45° FOV, retinal fundus photograph, 2352 x 1568 pixels
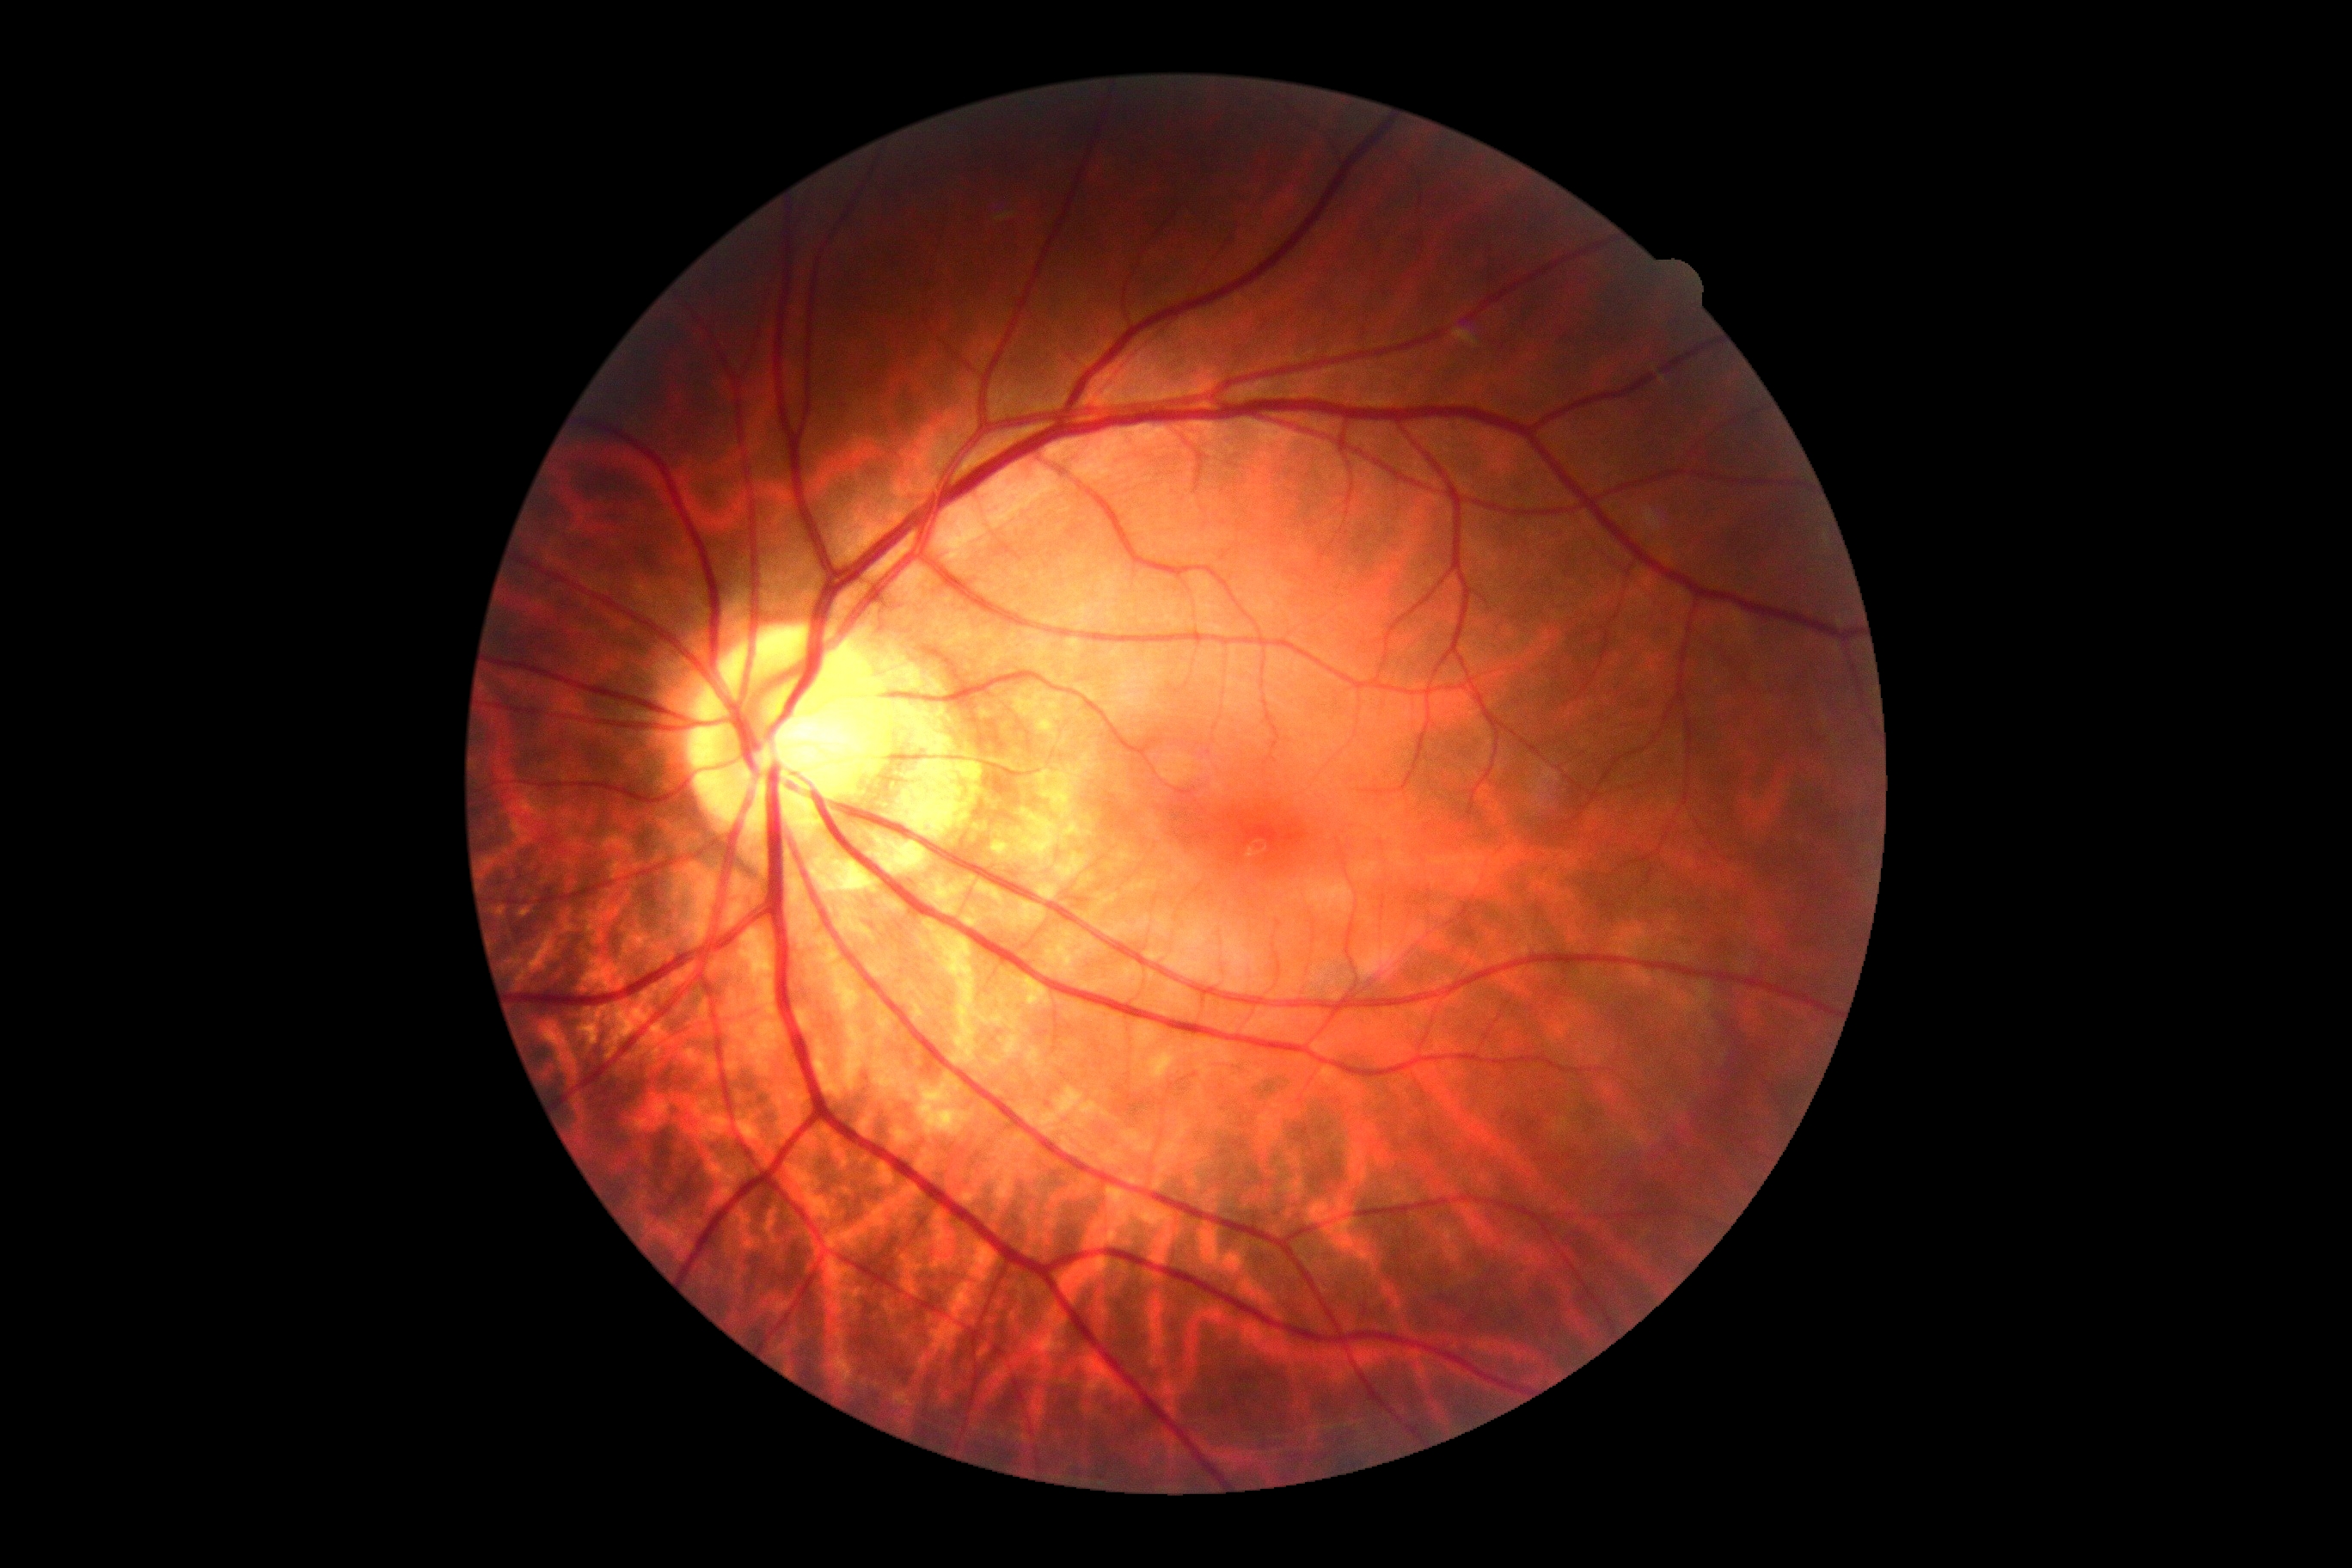 DR severity: no apparent diabetic retinopathy (grade 0).